Pediatric wide-field fundus photograph; image size 1240x1240: 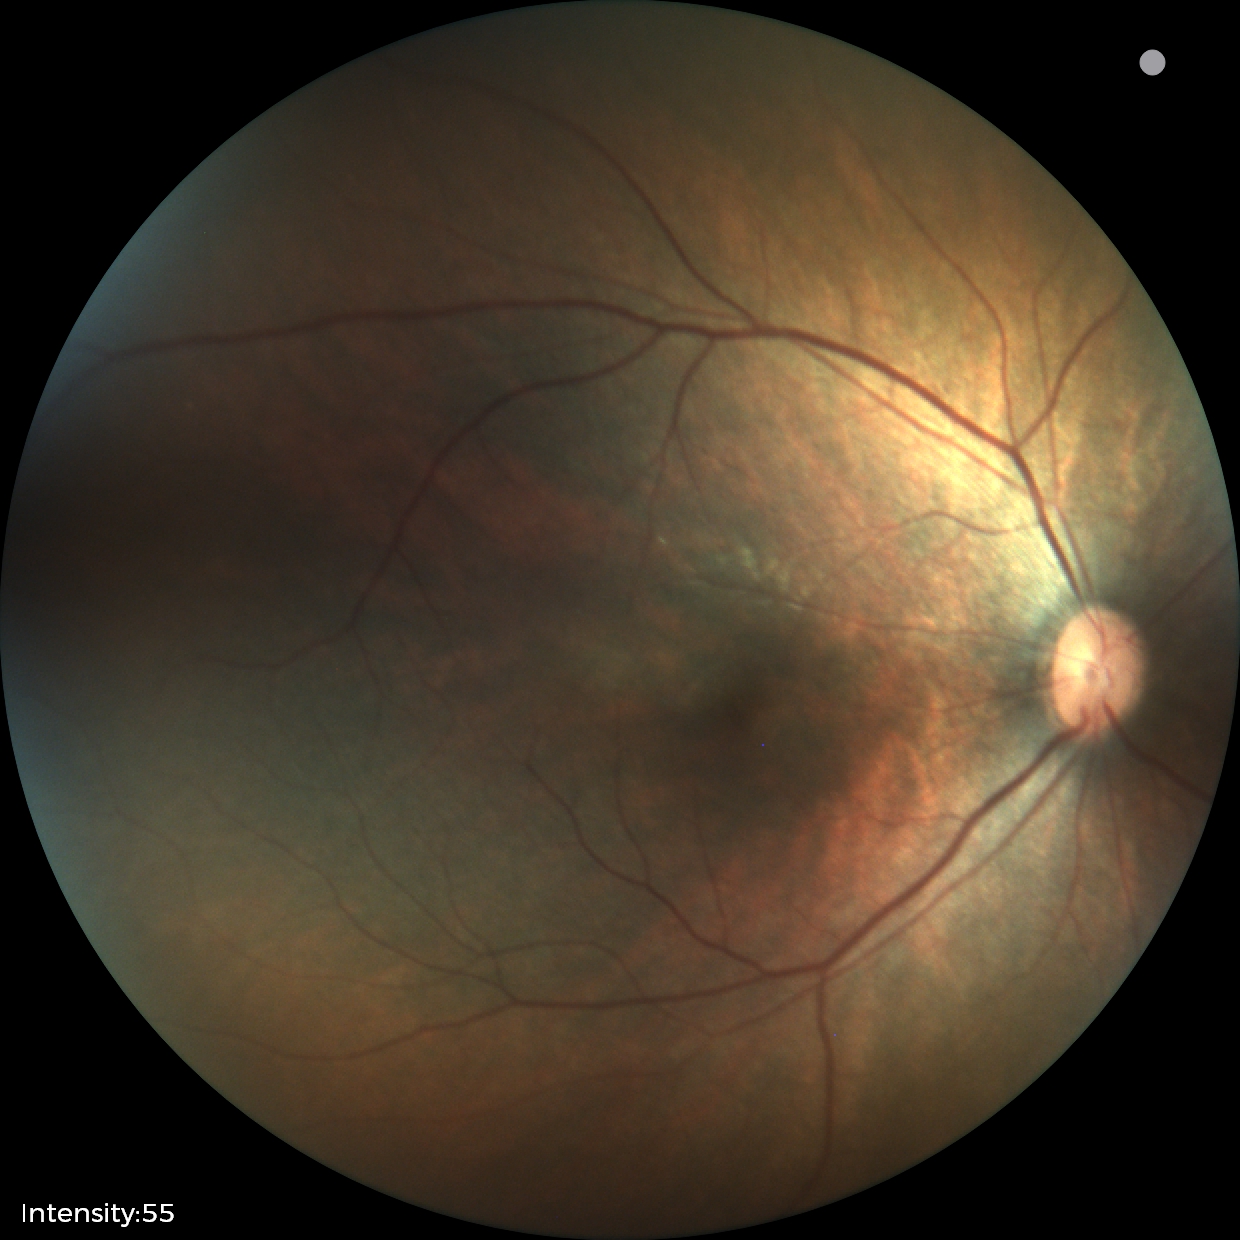
Impression: normal retinal appearance.